Wide-field fundus image from infant ROP screening: 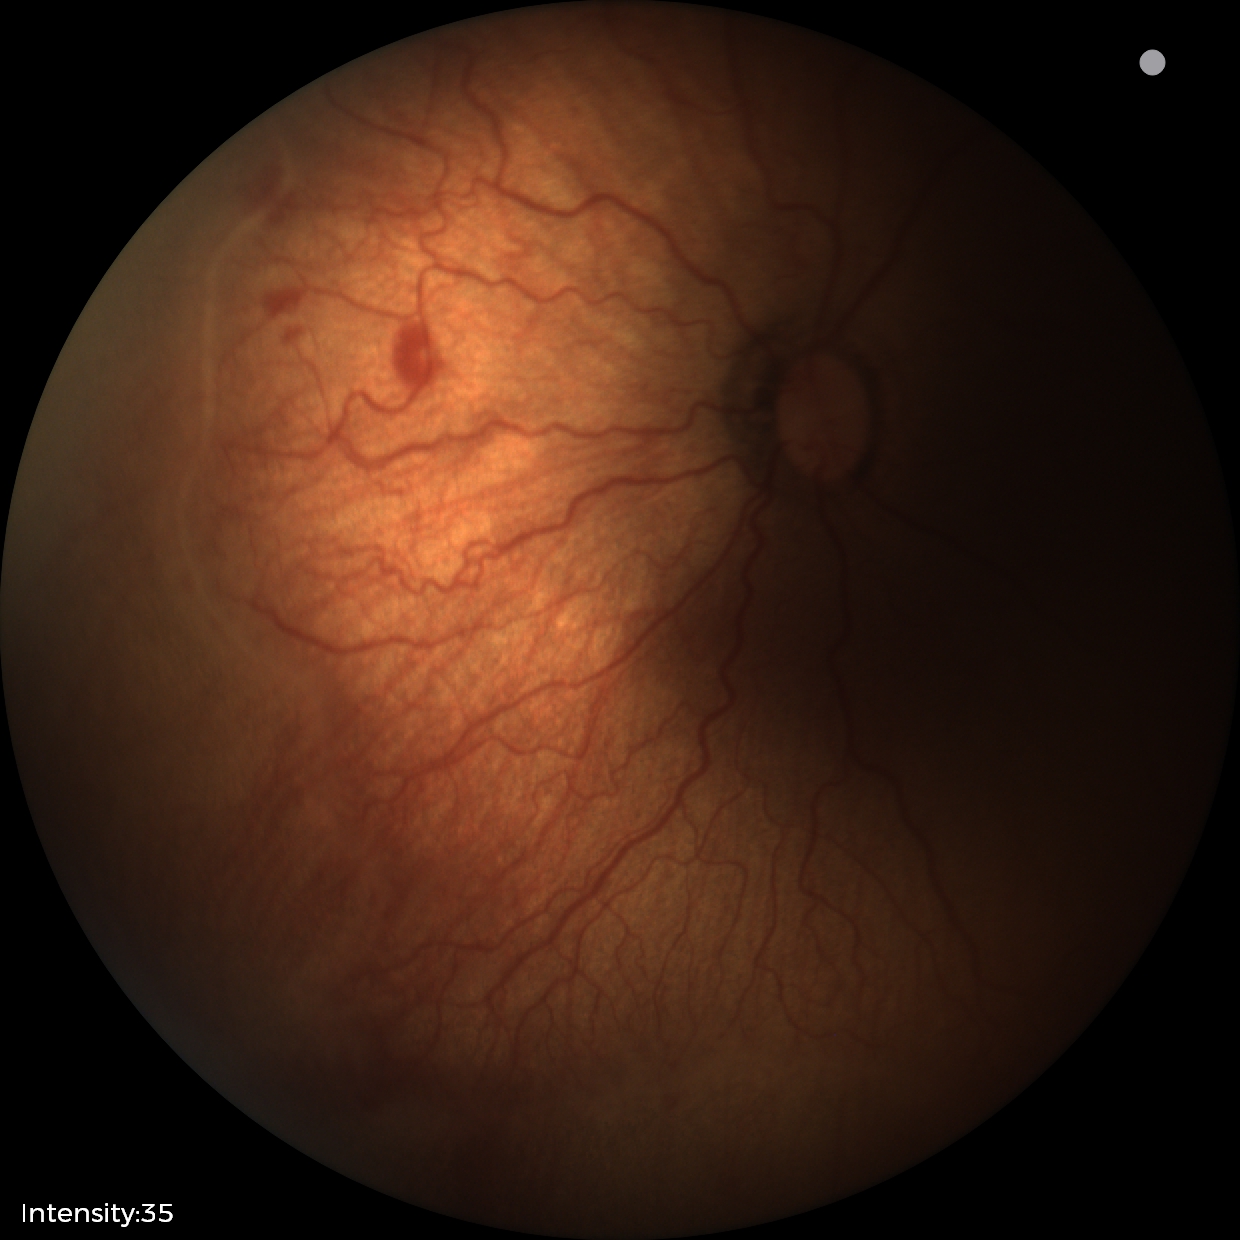
Series diagnosed as ROP stage 2.
With plus disease.